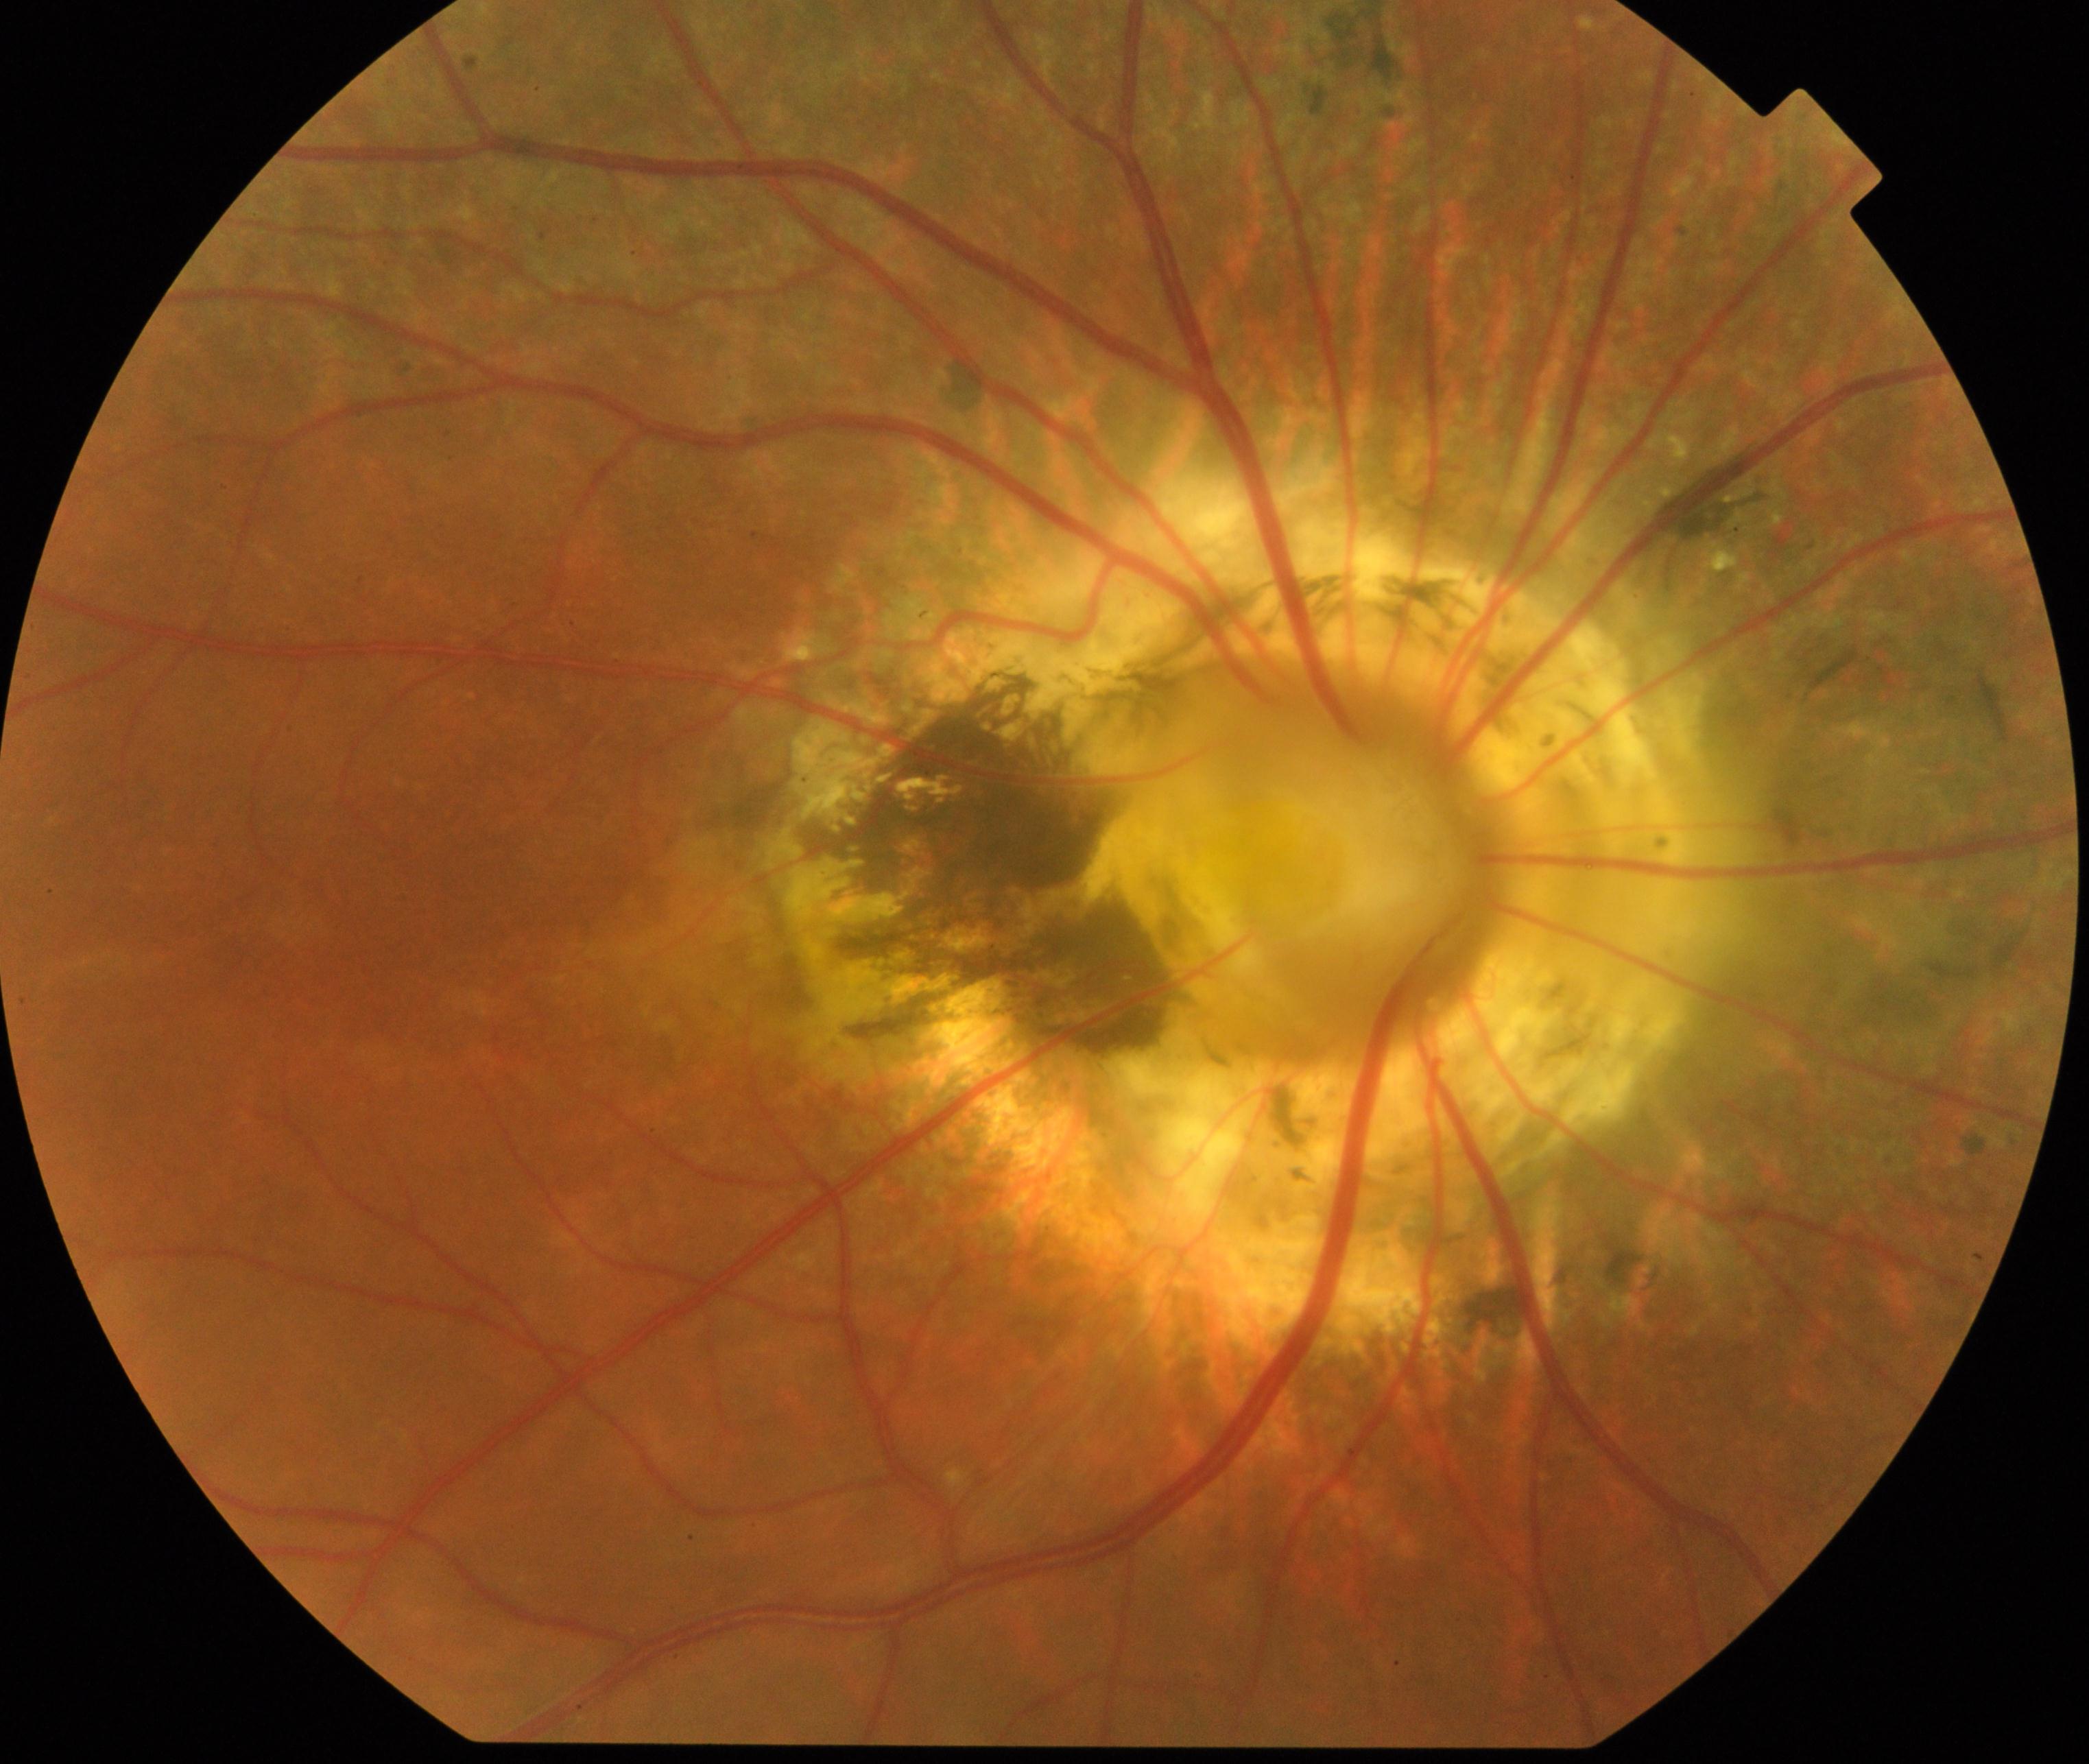

Findings: congenital disc abnormality.